45° field of view. 2352 by 1568 pixels. Retinal fundus photograph.
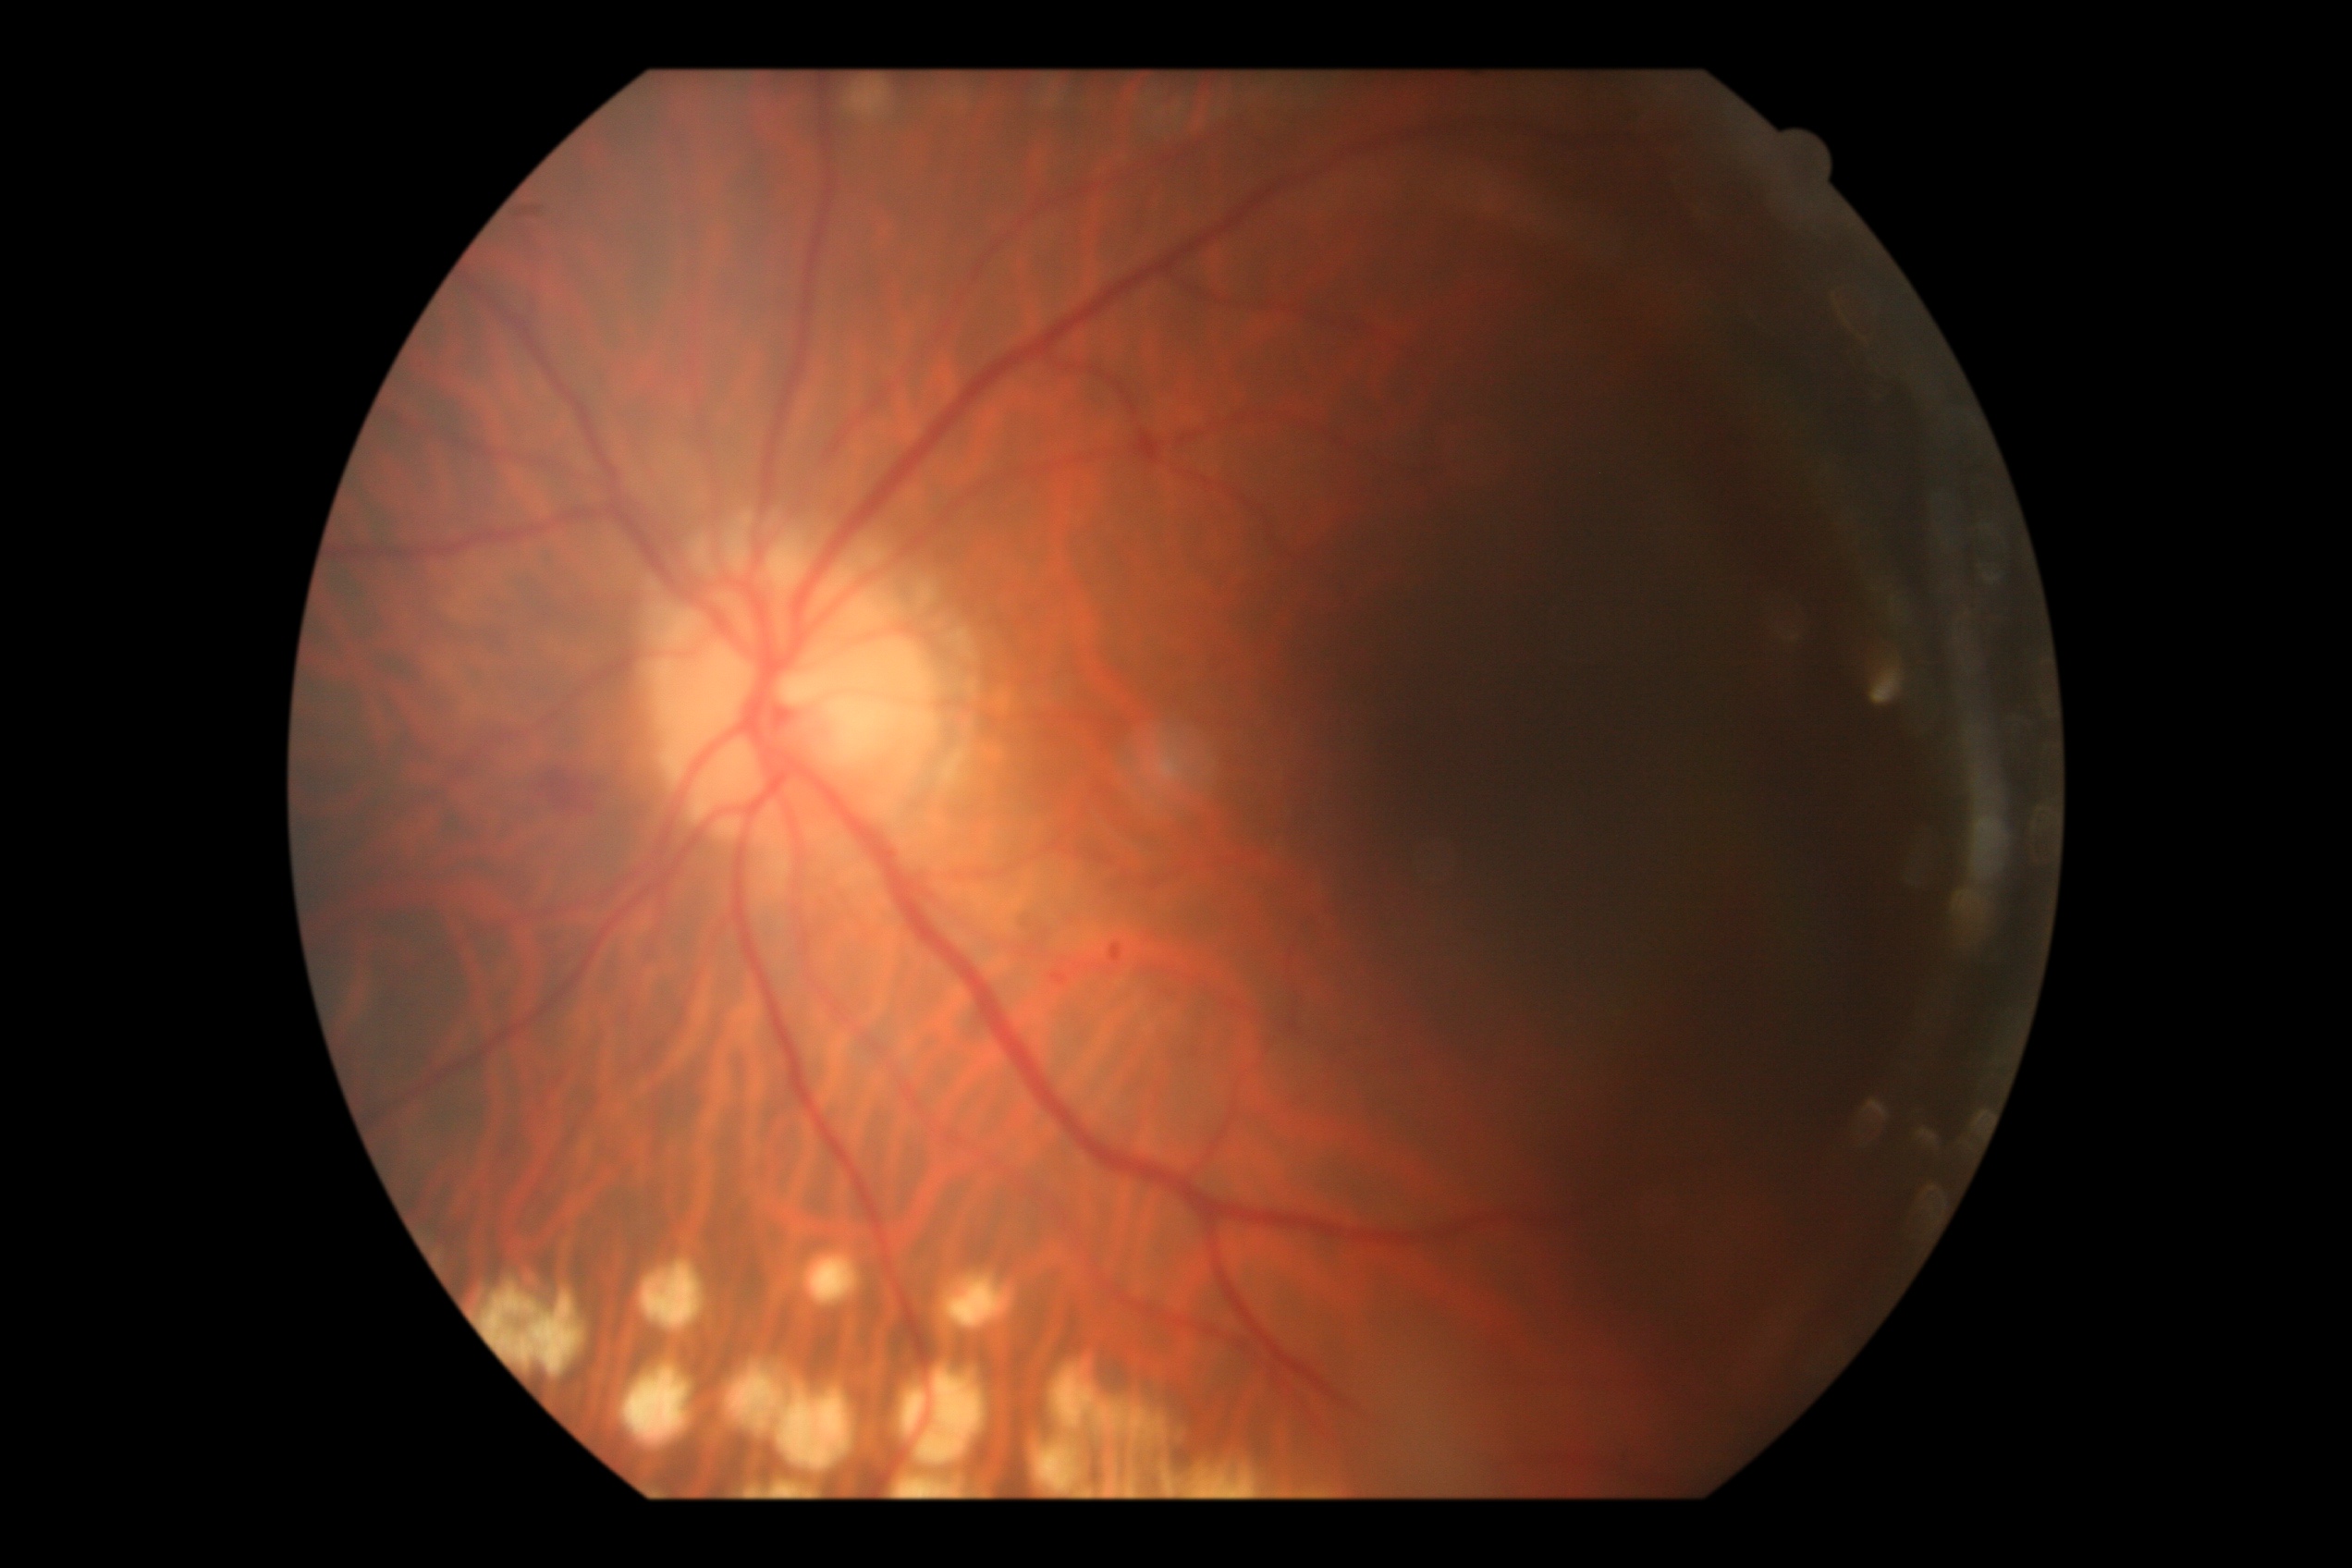

dr_grade: moderate NPDR (grade 2)